Color fundus image:
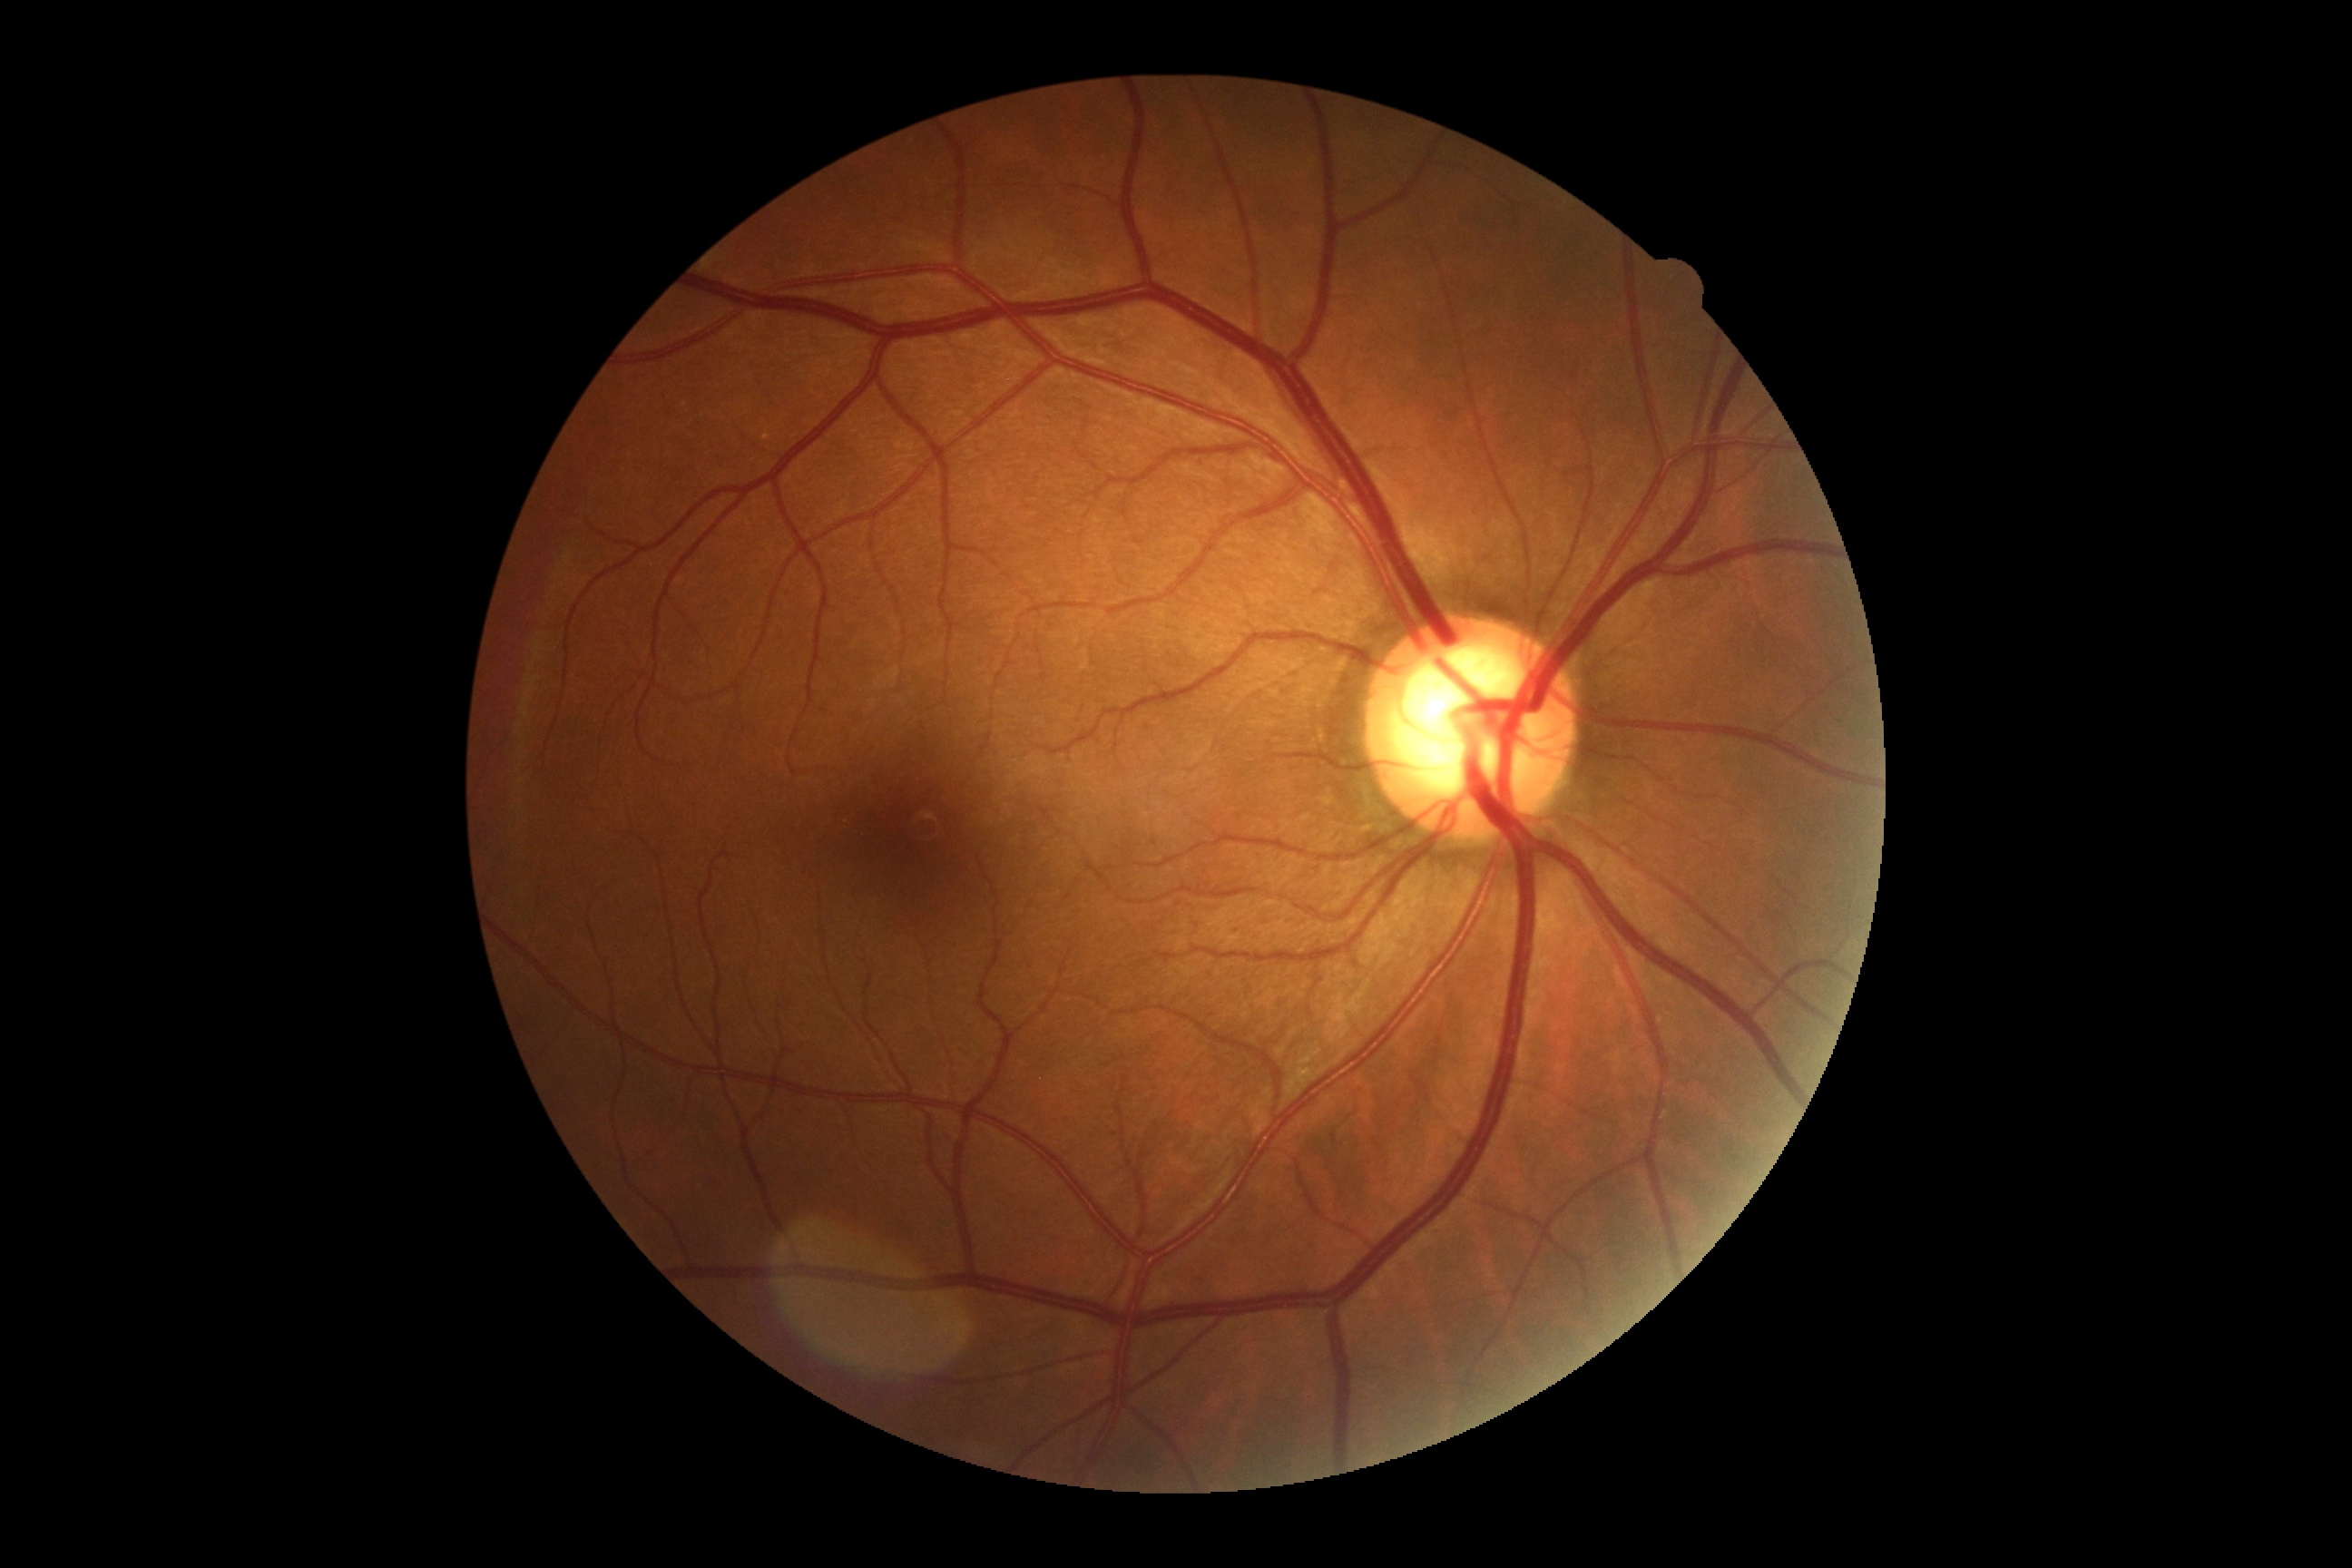 DR grade is 0.